Graded on the modified Davis scale · 848 x 848 pixels:
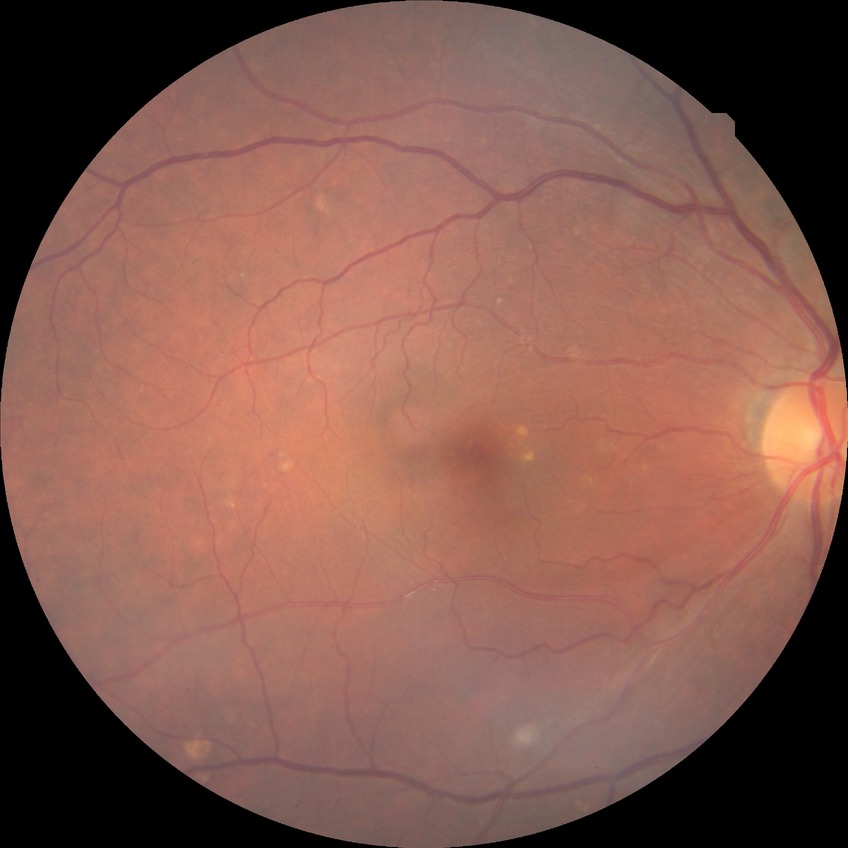 Retinopathy stage: no diabetic retinopathy.